Fundus photo. 240 by 240 pixels. Non-mydriatic acquisition.
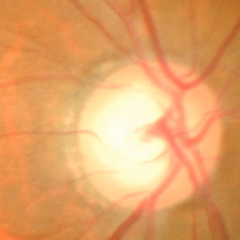 Glaucoma diagnosis = advanced-stage glaucoma.